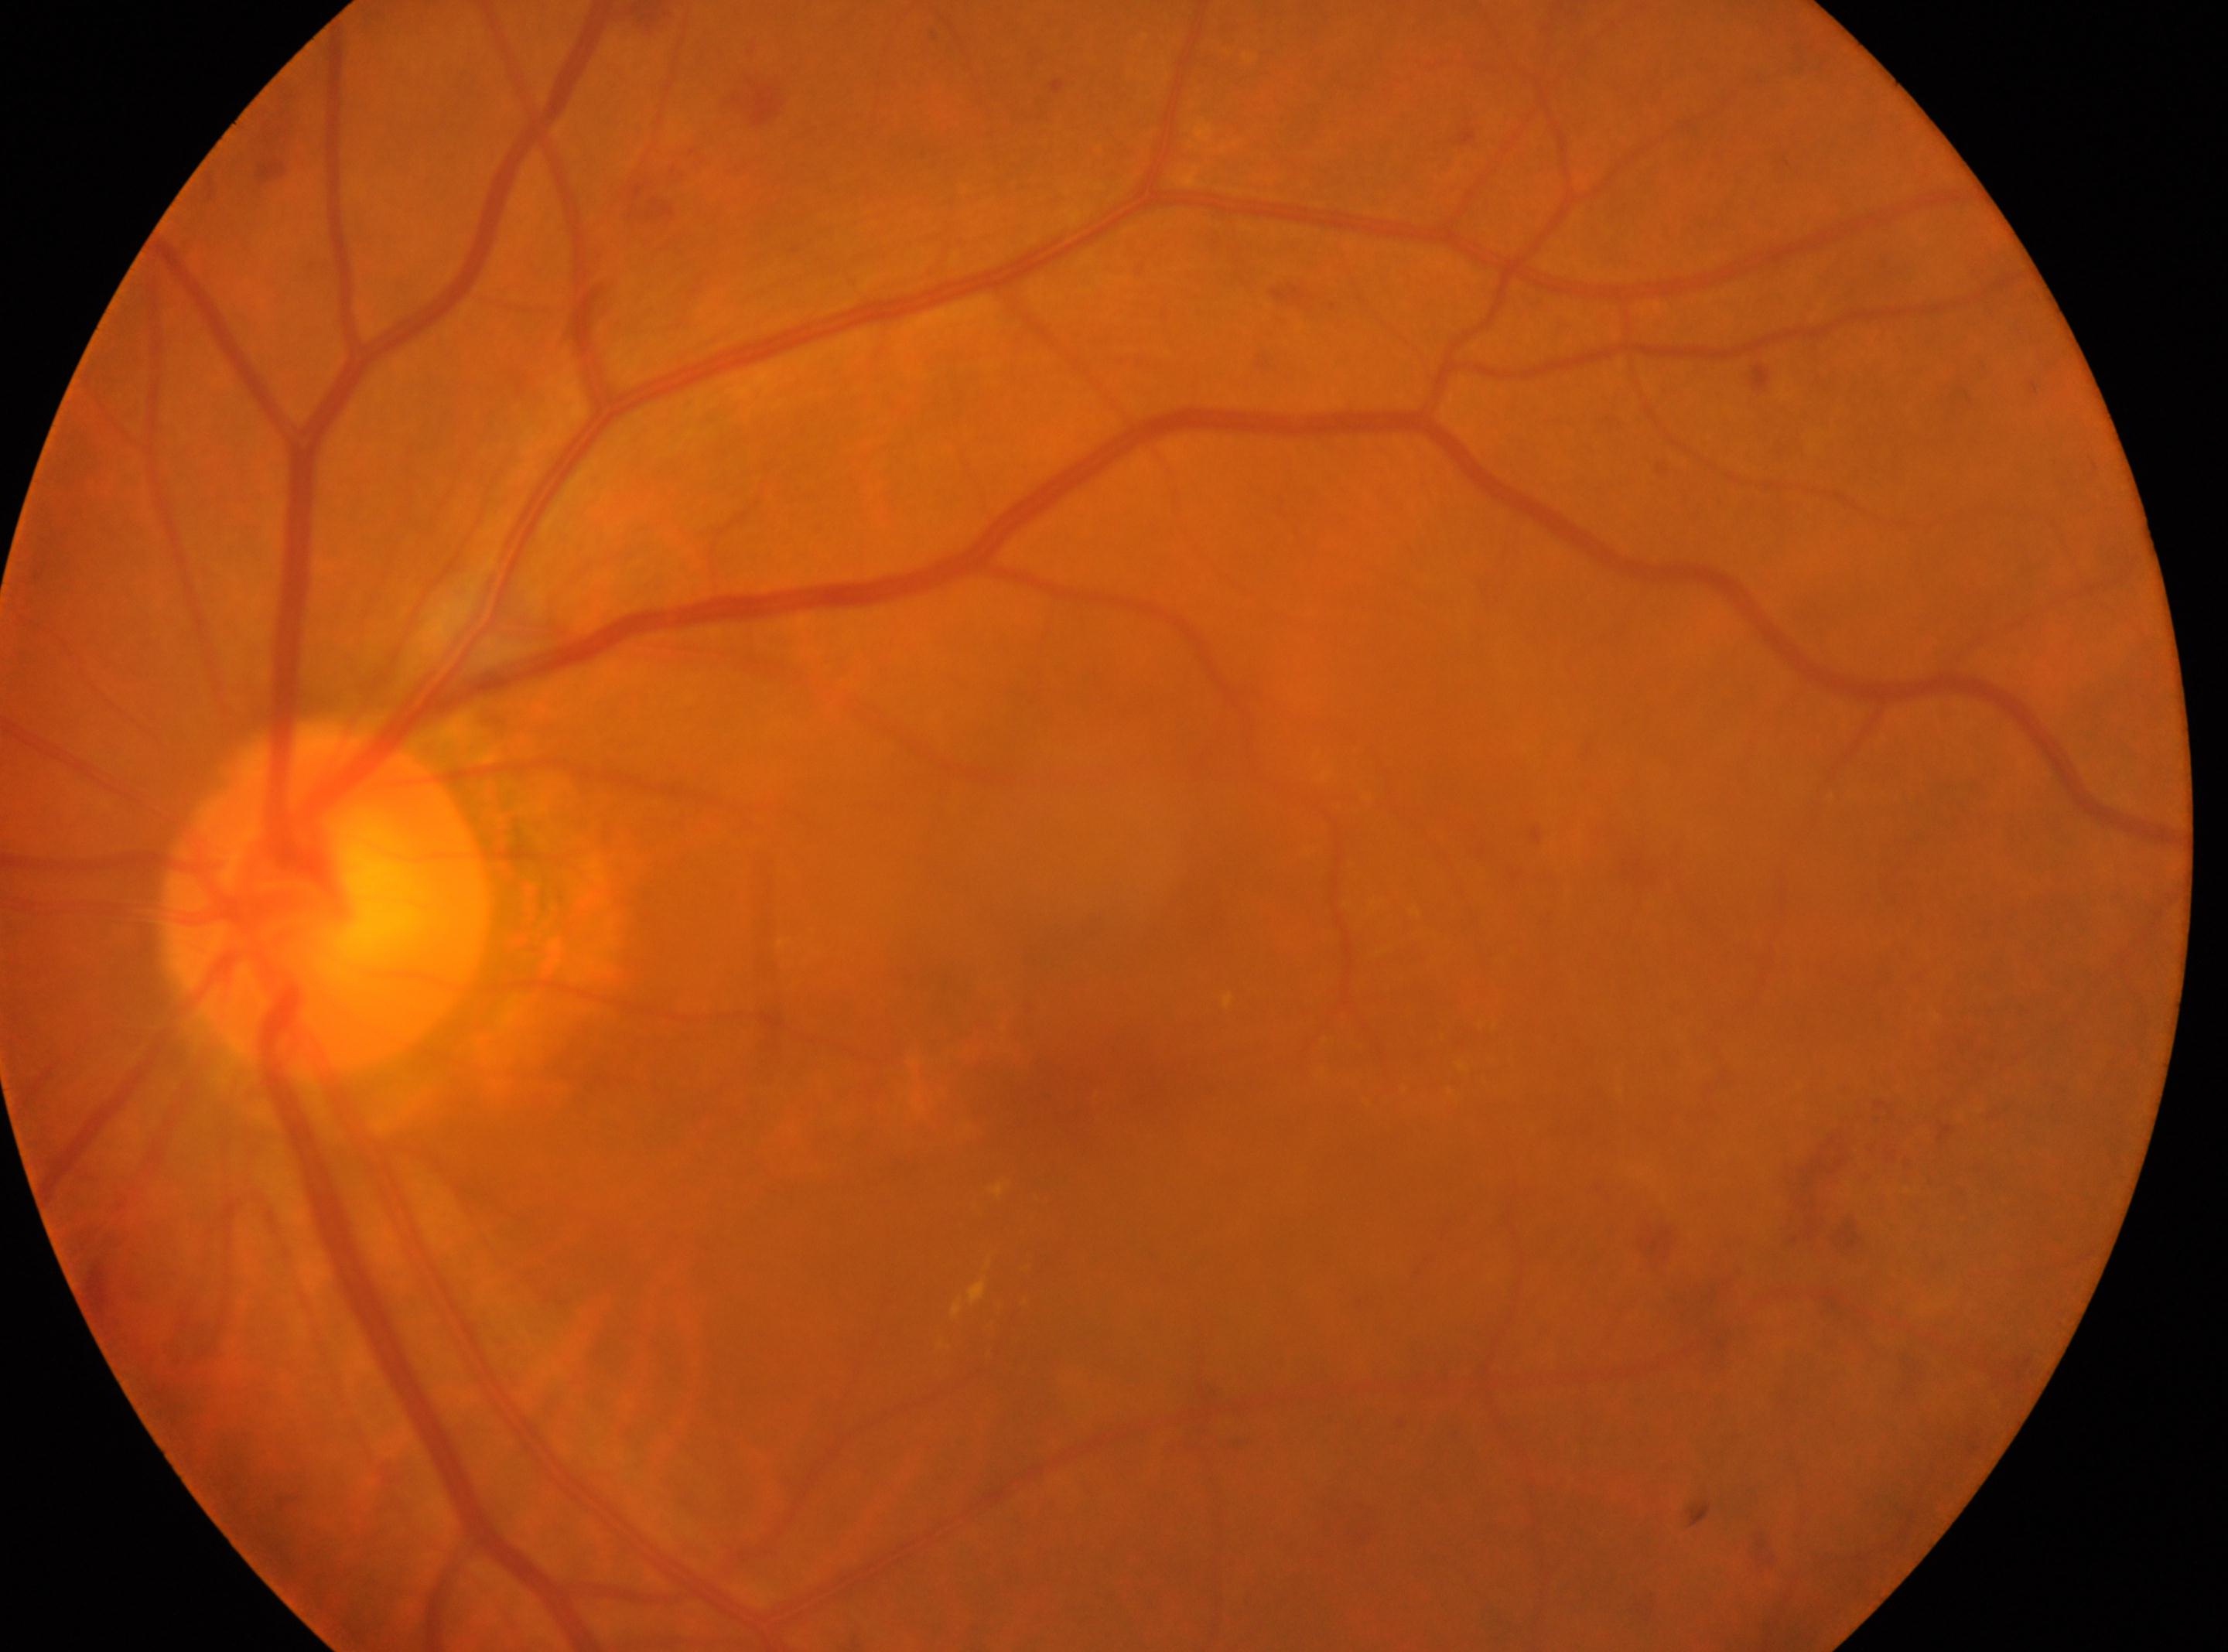
* macula center · 1078px, 1095px
* optic disk · 325px, 899px
* diabetic retinopathy (DR) · grade 2 (moderate NPDR)
* eye · OS